NIDEK AFC-230; nonmydriatic; modified Davis classification
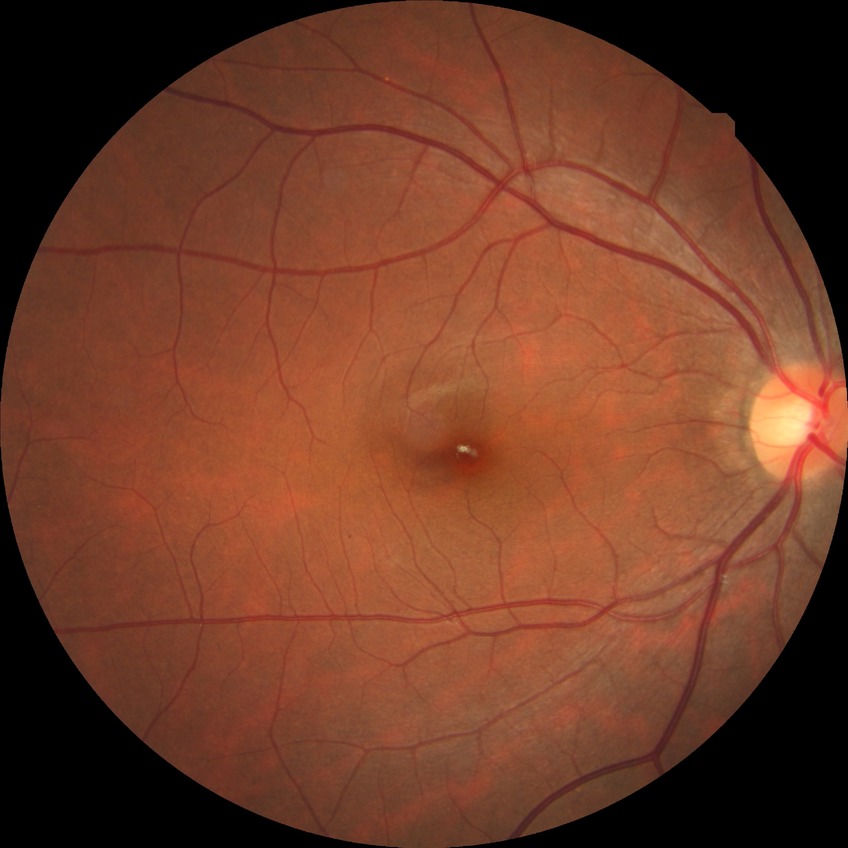
Assessment:
• DR stage — NDR